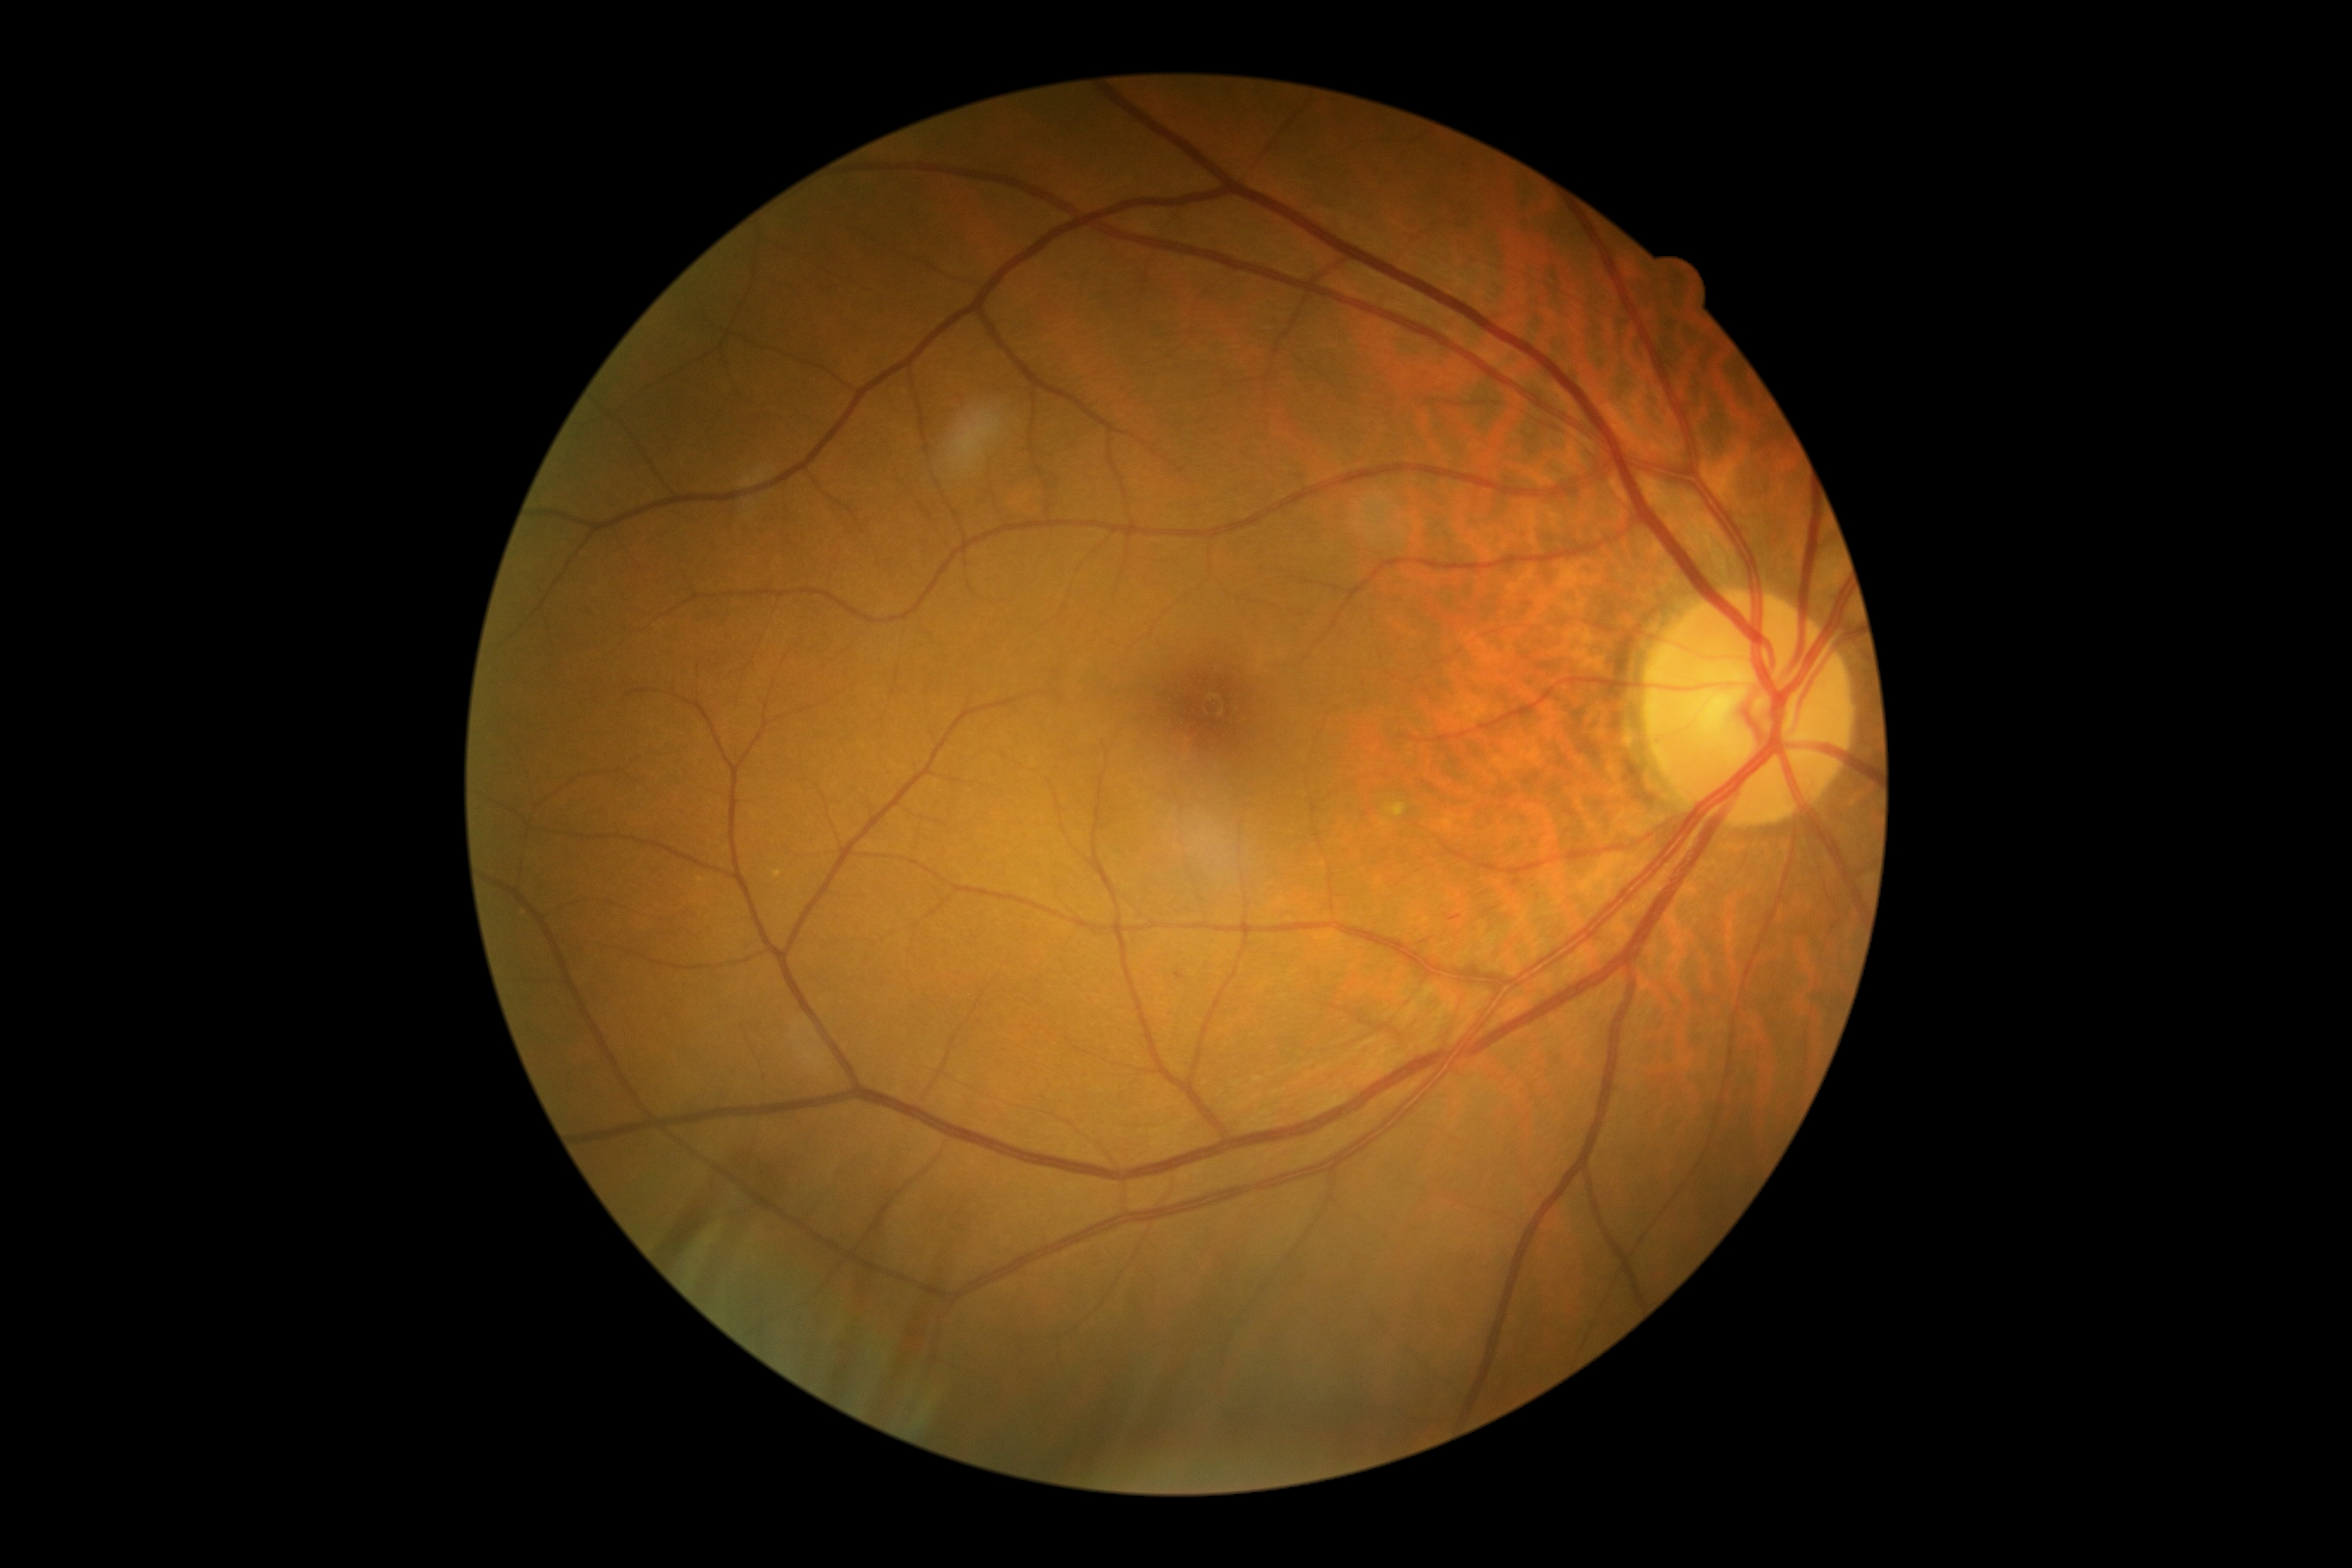
DR is grade 2 (moderate NPDR) — more than just microaneurysms but less than severe NPDR.